Phoenix ICON, 100° FOV. Phoenix ICON wide-field infant fundus image: 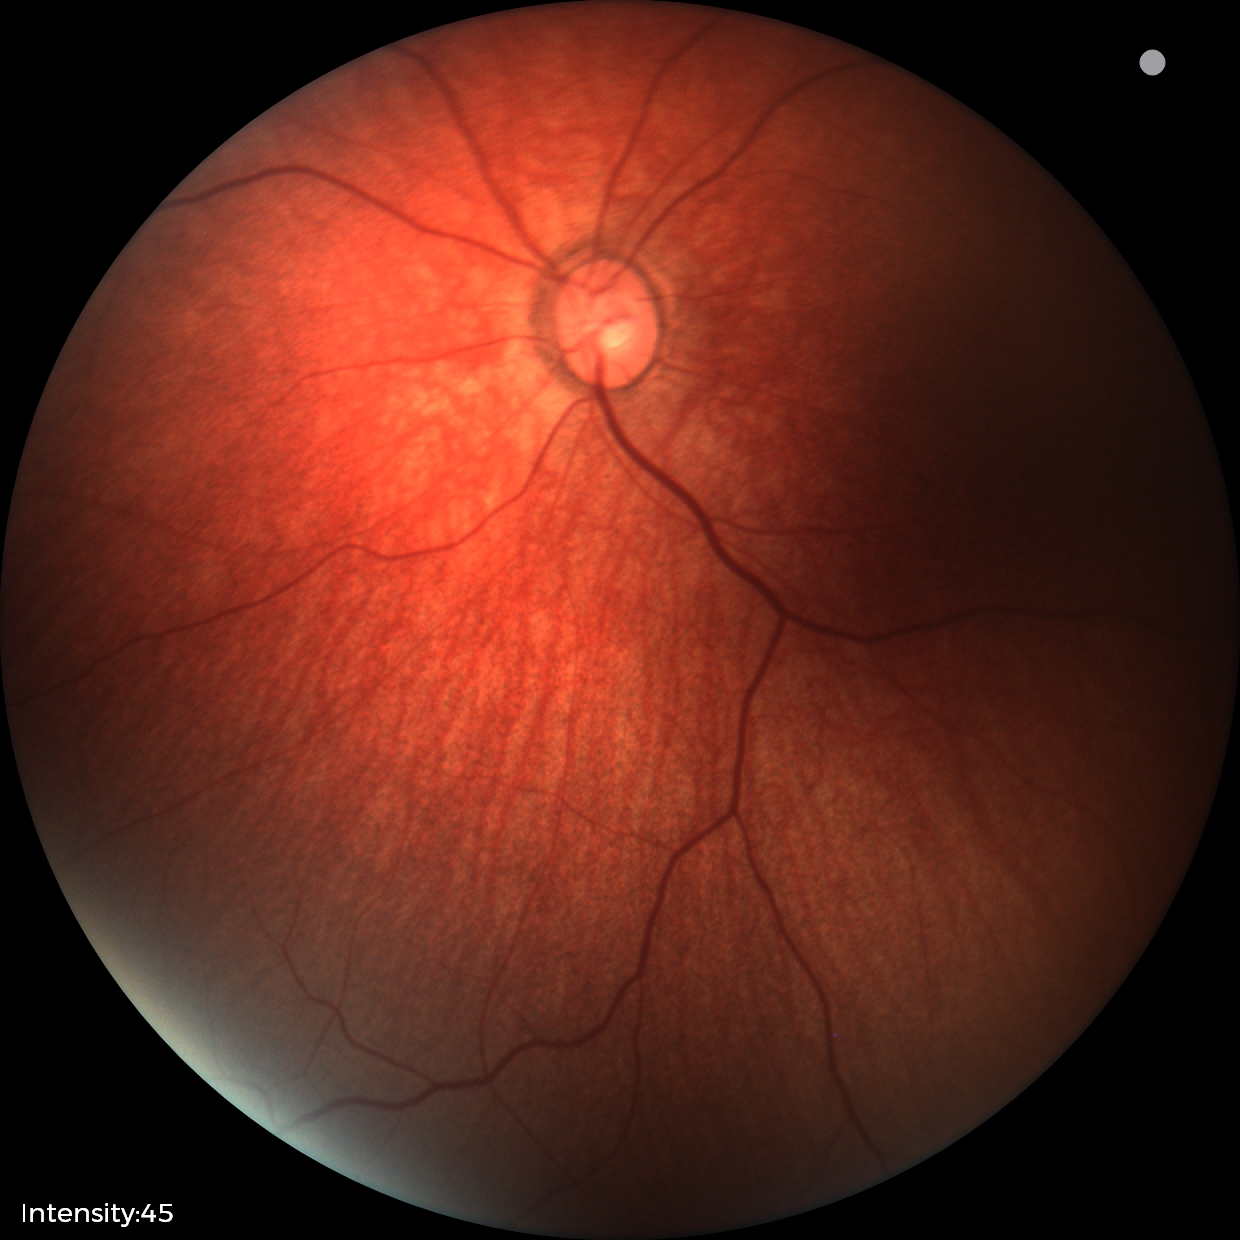

Screening examination diagnosed as physiological.